130° field of view (Clarity RetCam 3); wide-field contact fundus photograph of an infant; 640 x 480 pixels:
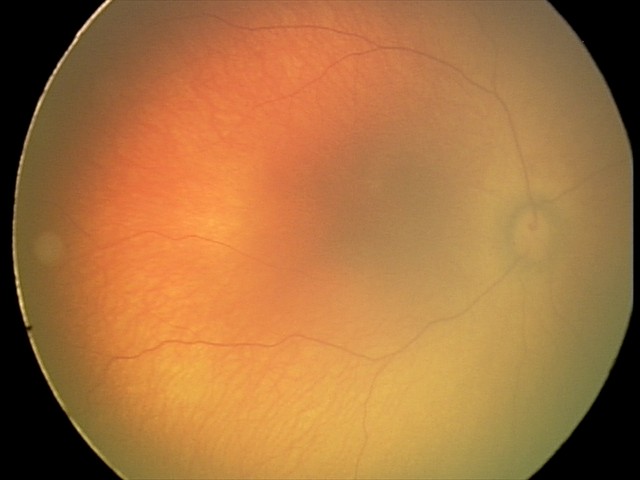

Assessment: physiological.